640 by 480 pixels; wide-field contact fundus photograph of an infant; acquired on the Clarity RetCam 3
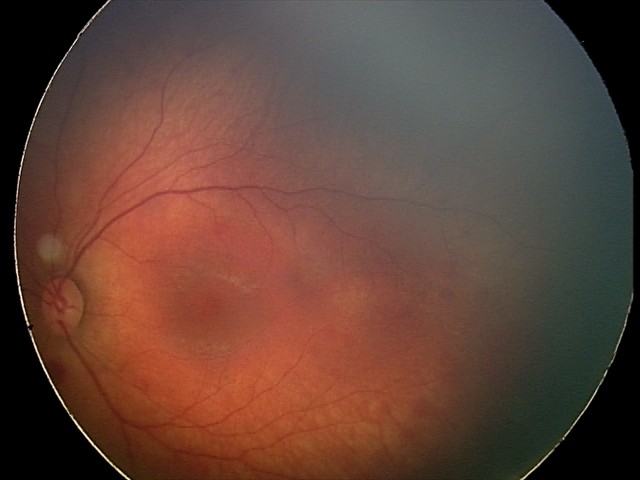 From an examination with diagnosis of retinal hemorrhages.